Infant wide-field retinal image; 100° field of view (Phoenix ICON):
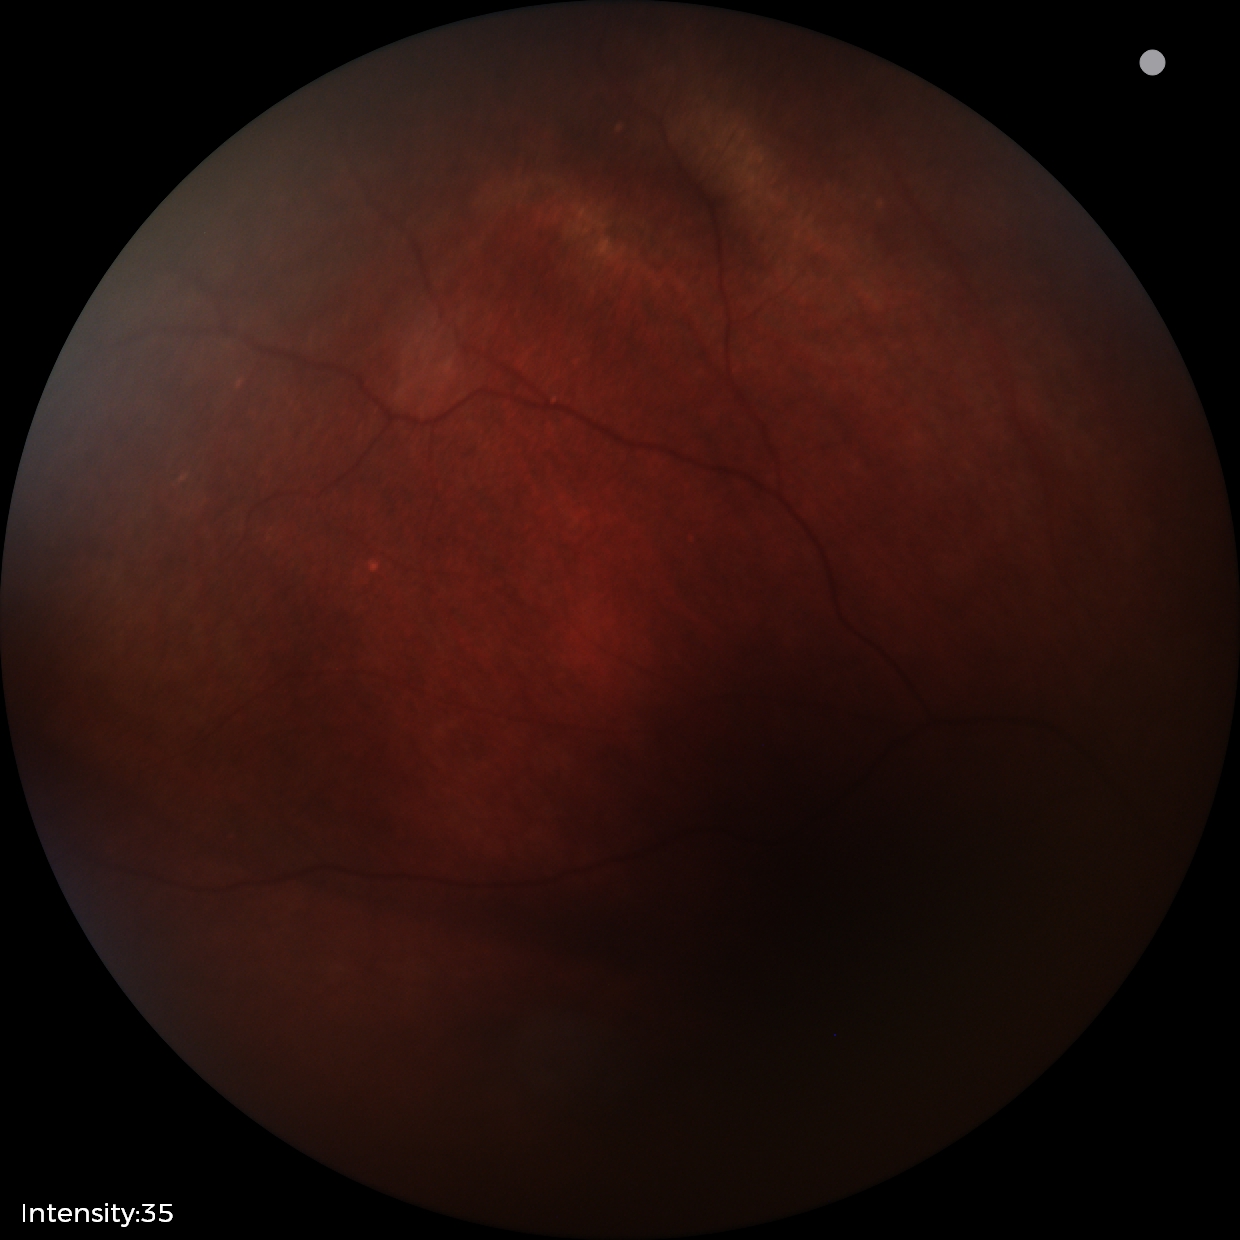
From an examination with diagnosis of retinal astrocytic hamartoma.